Davis DR grading, NIDEK AFC-230 fundus camera: 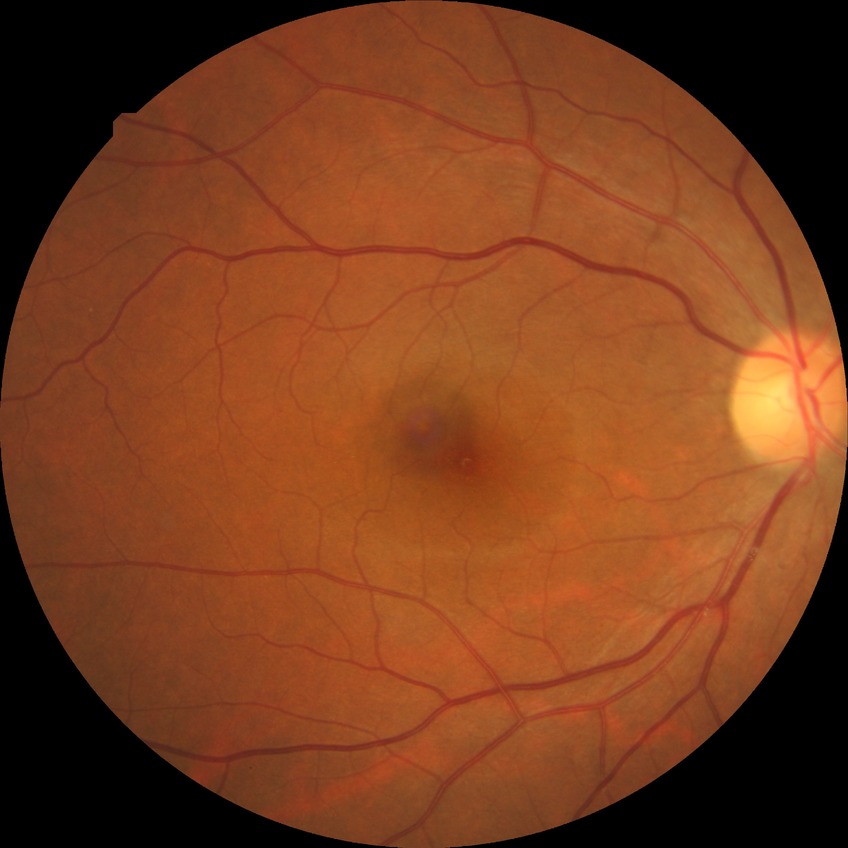
No signs of diabetic retinopathy. DR is NDR.